Color fundus image · 2352x1568 · 45° field of view
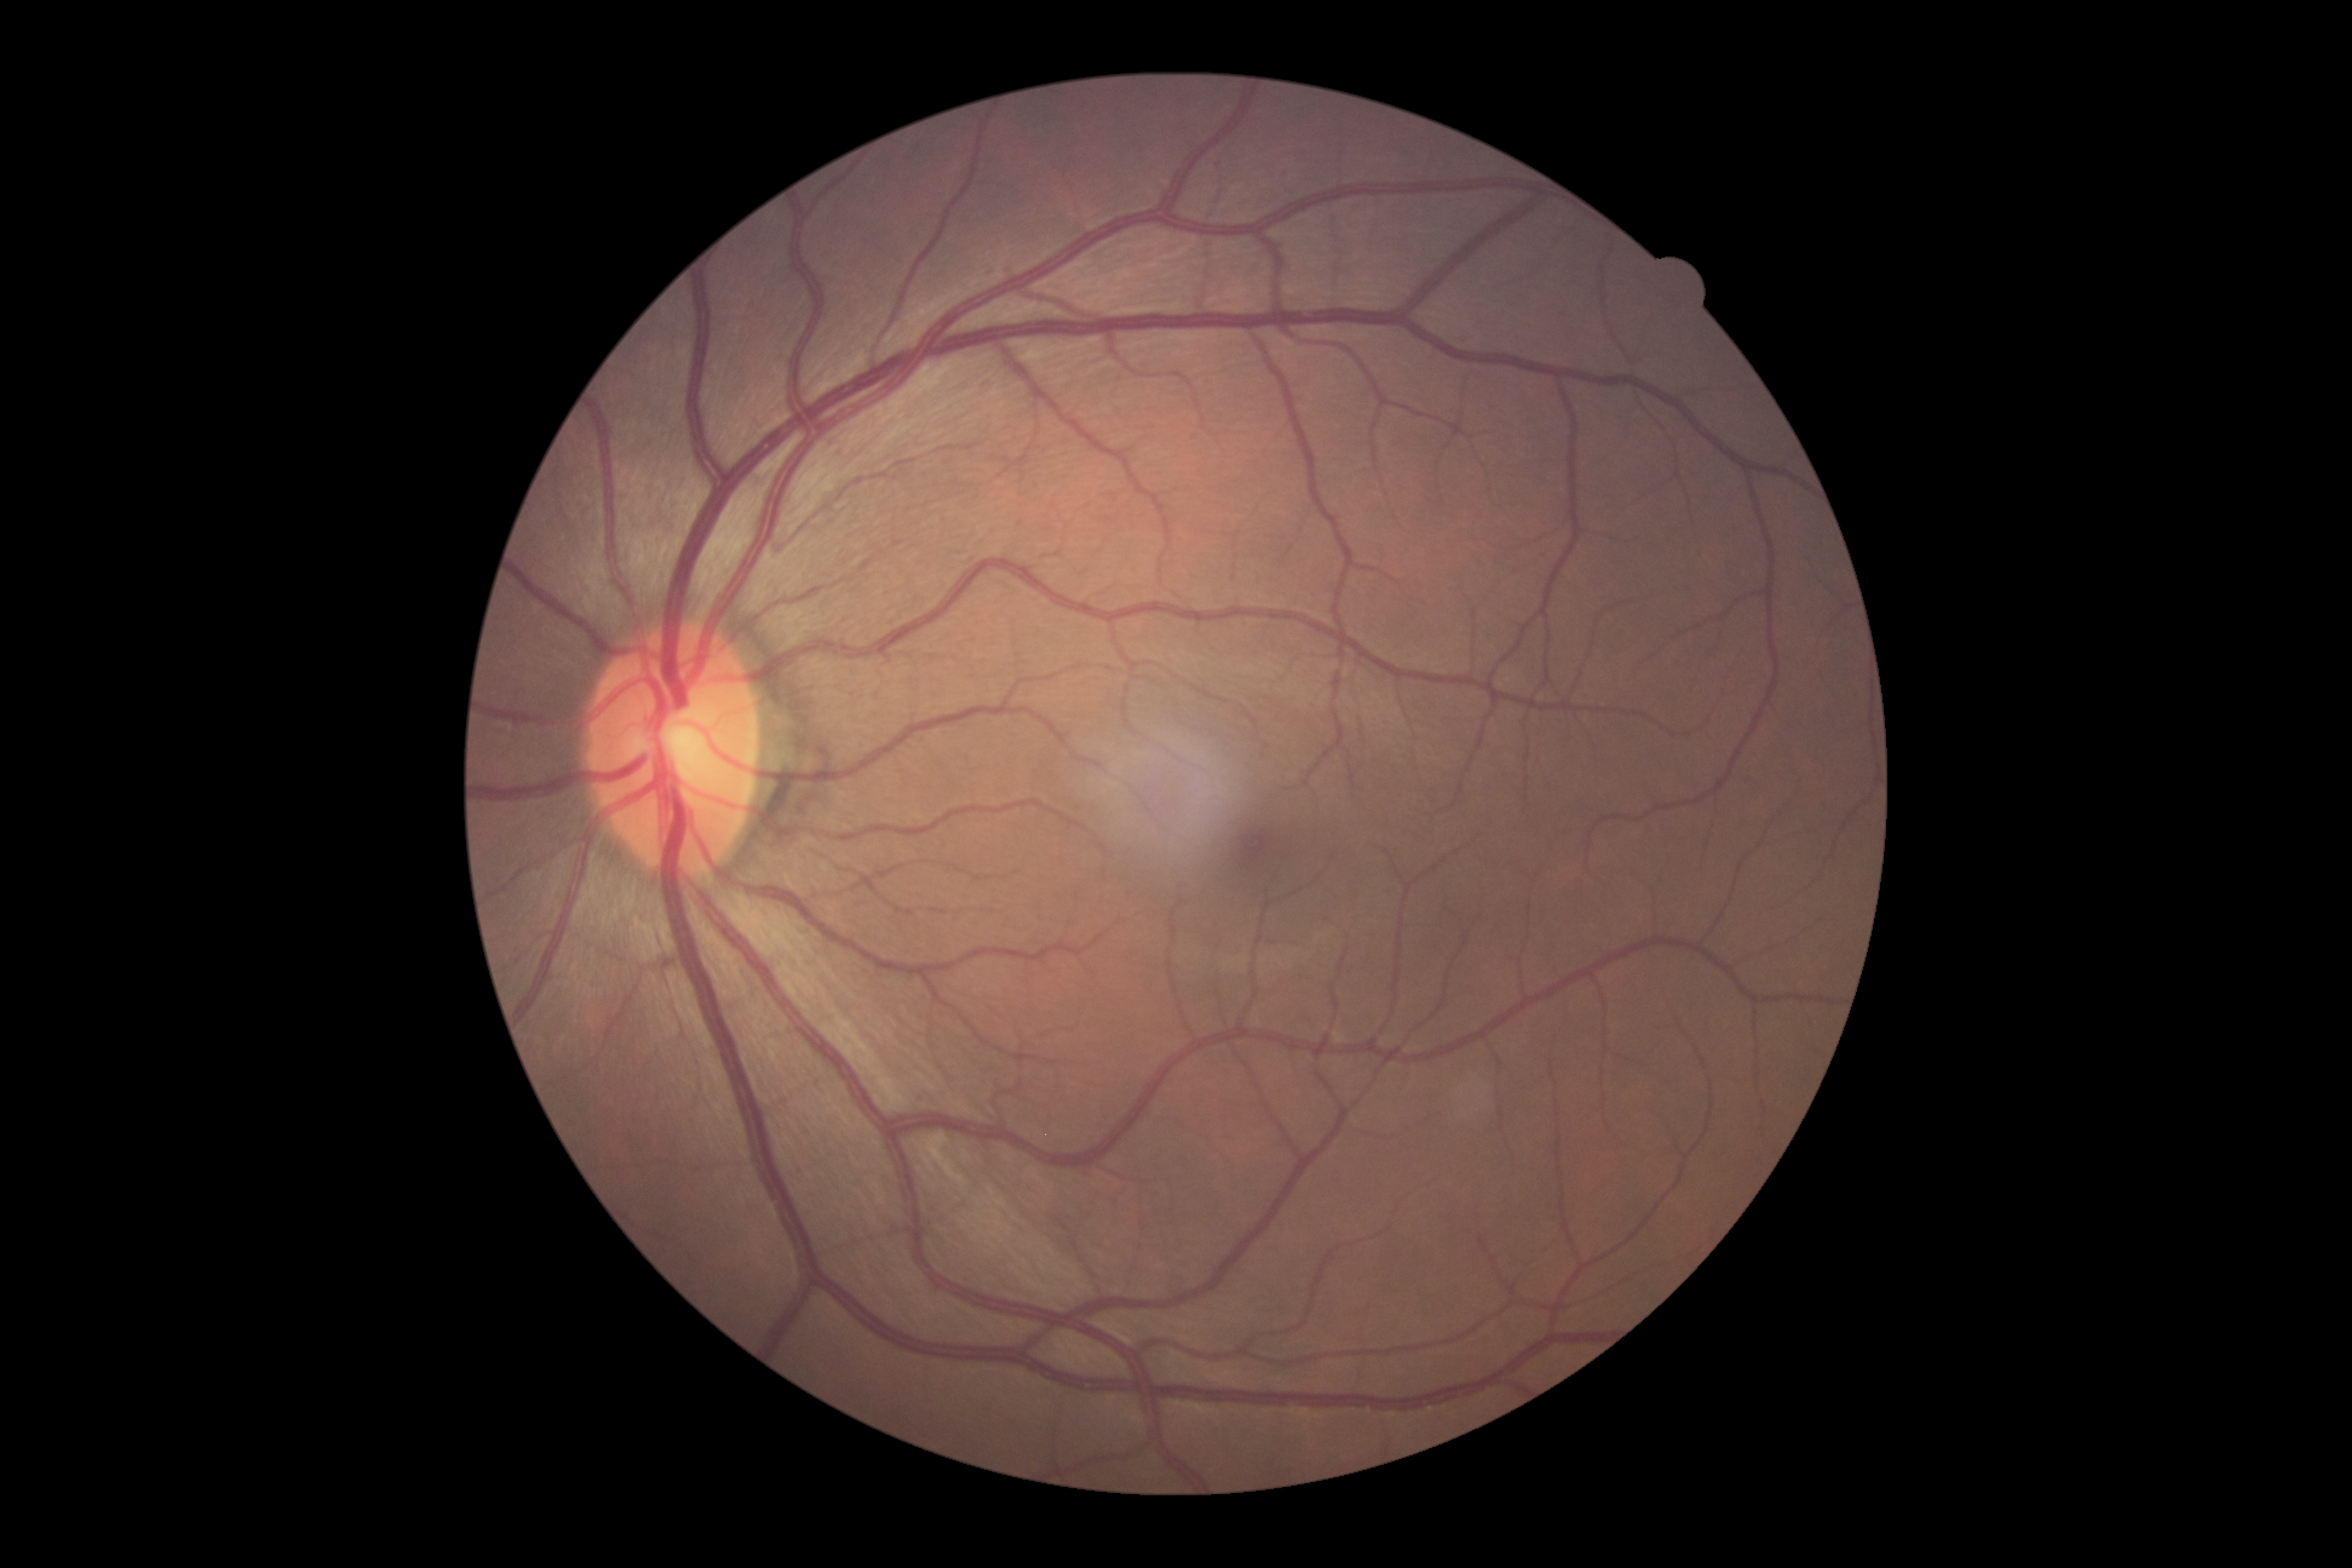
Diabetic retinopathy grade: 0 (no apparent retinopathy).